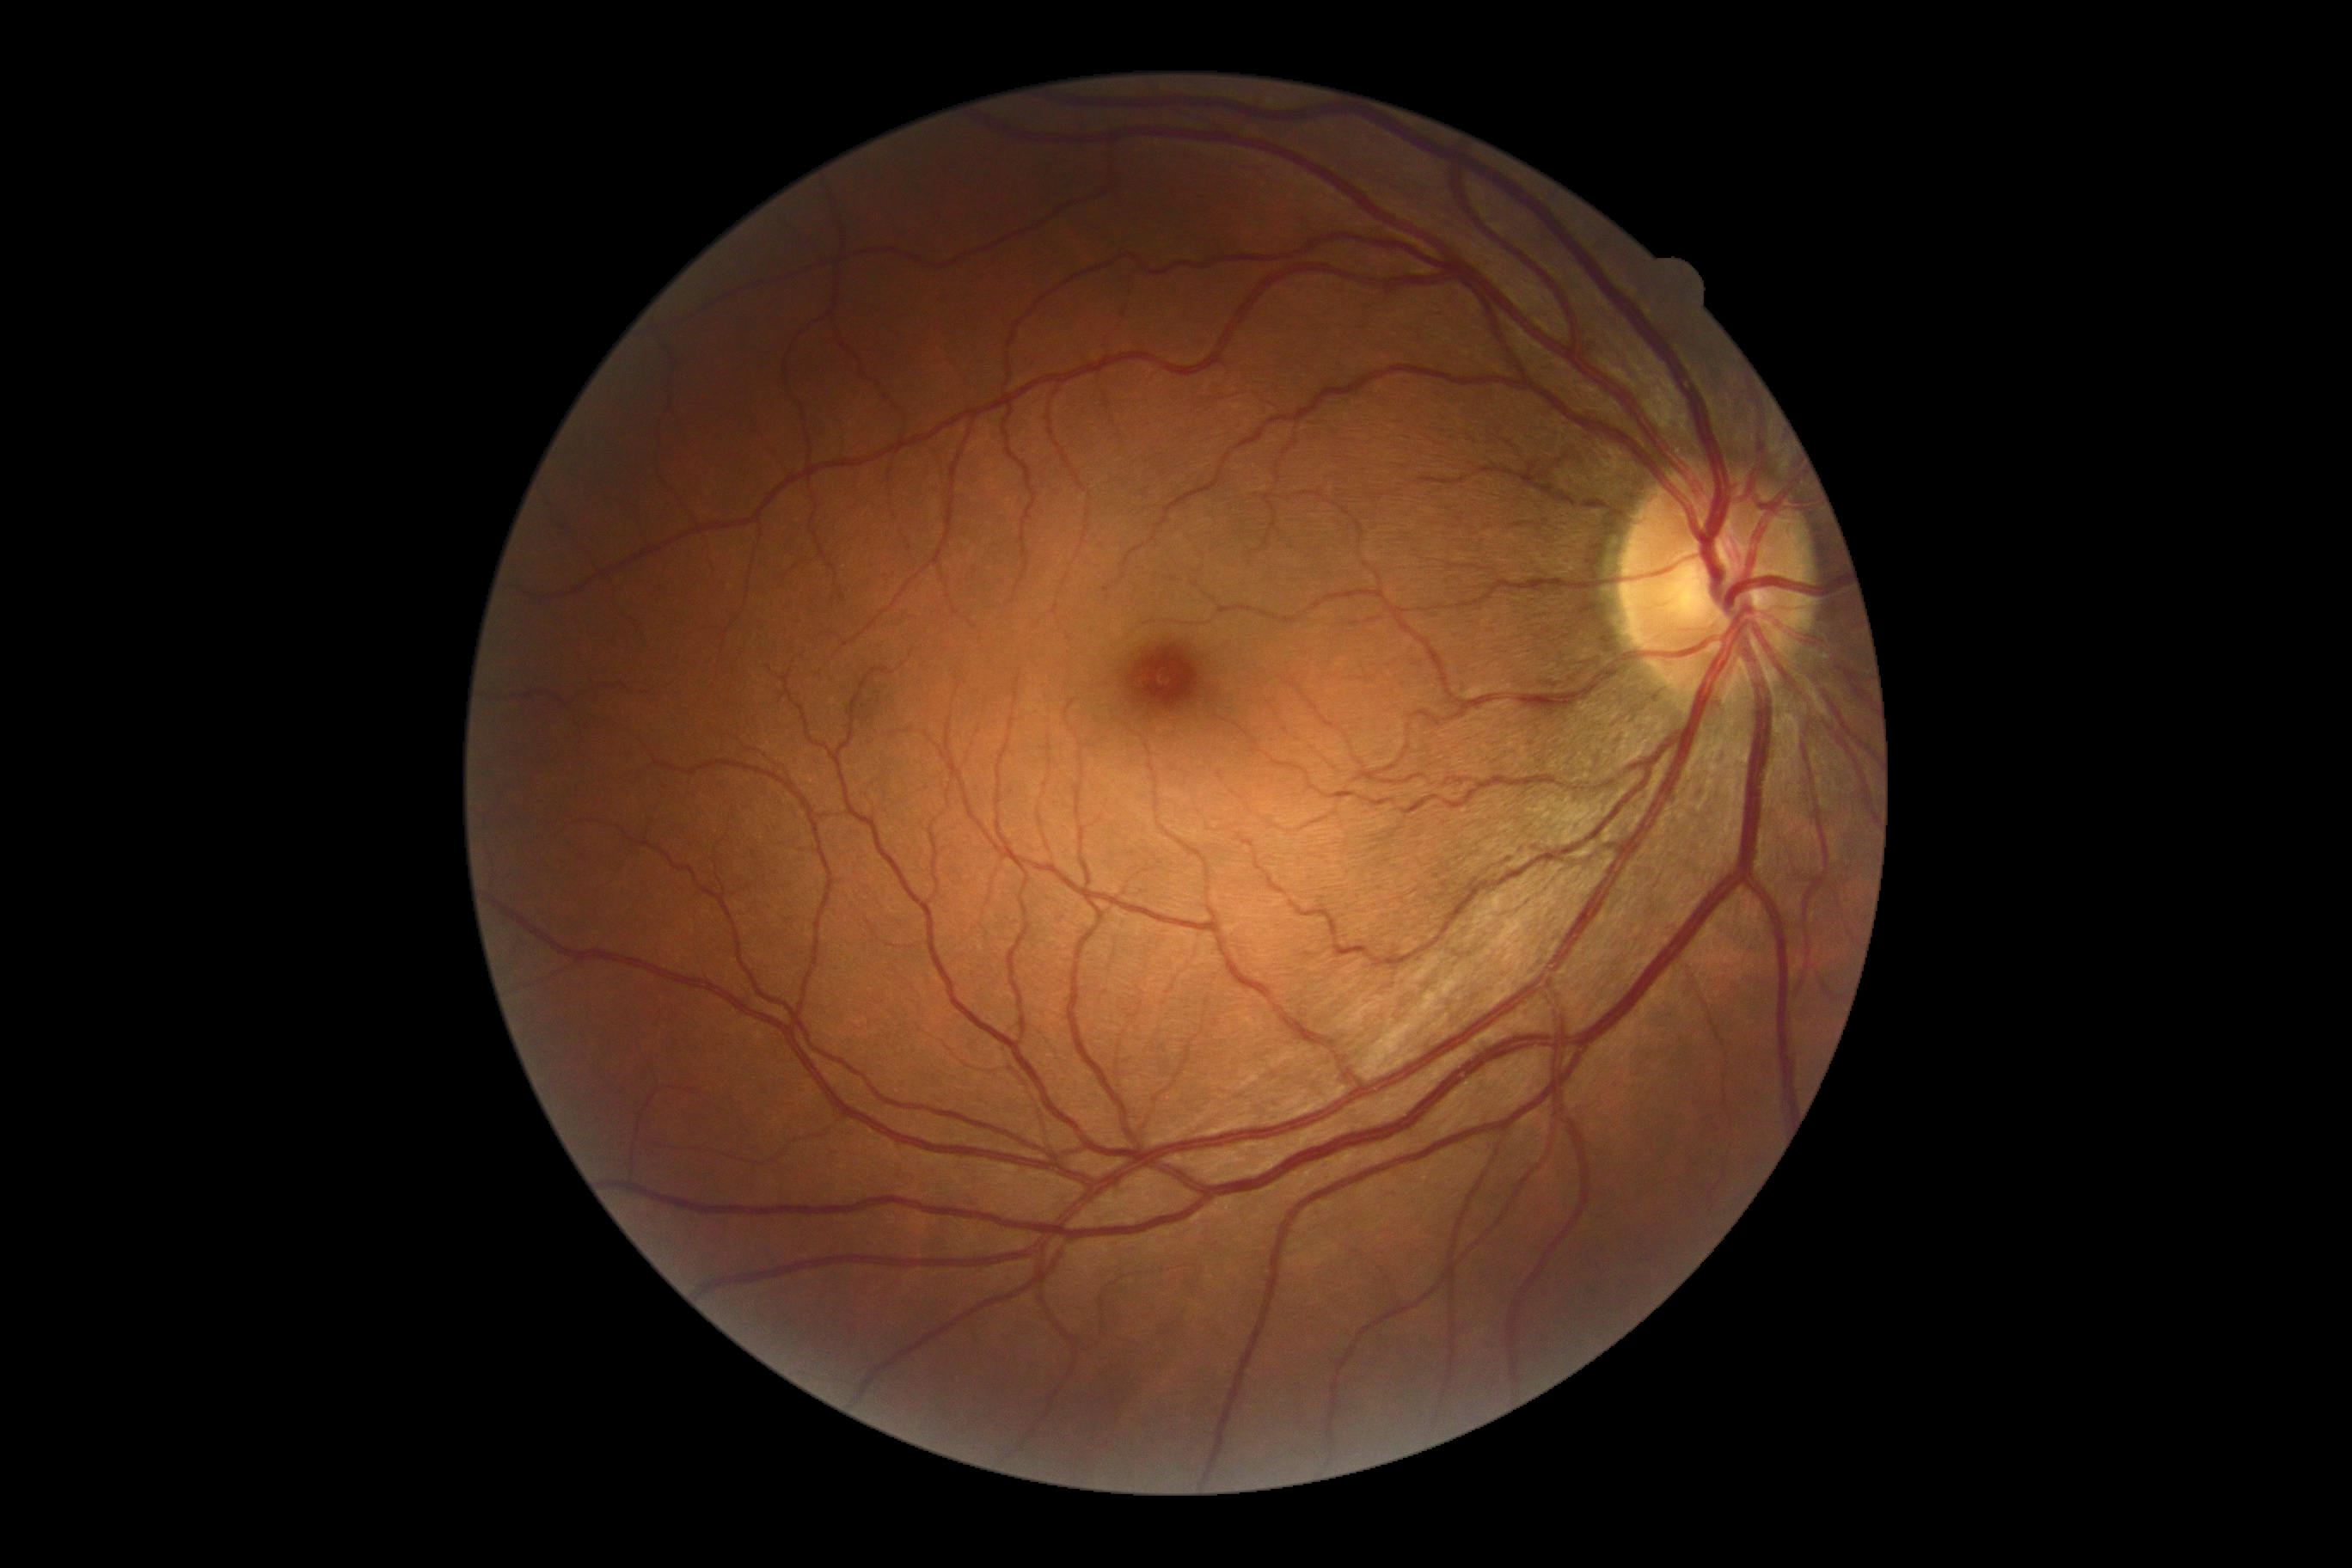
Diabetic retinopathy grade: 0/4 — no visible signs of diabetic retinopathy.